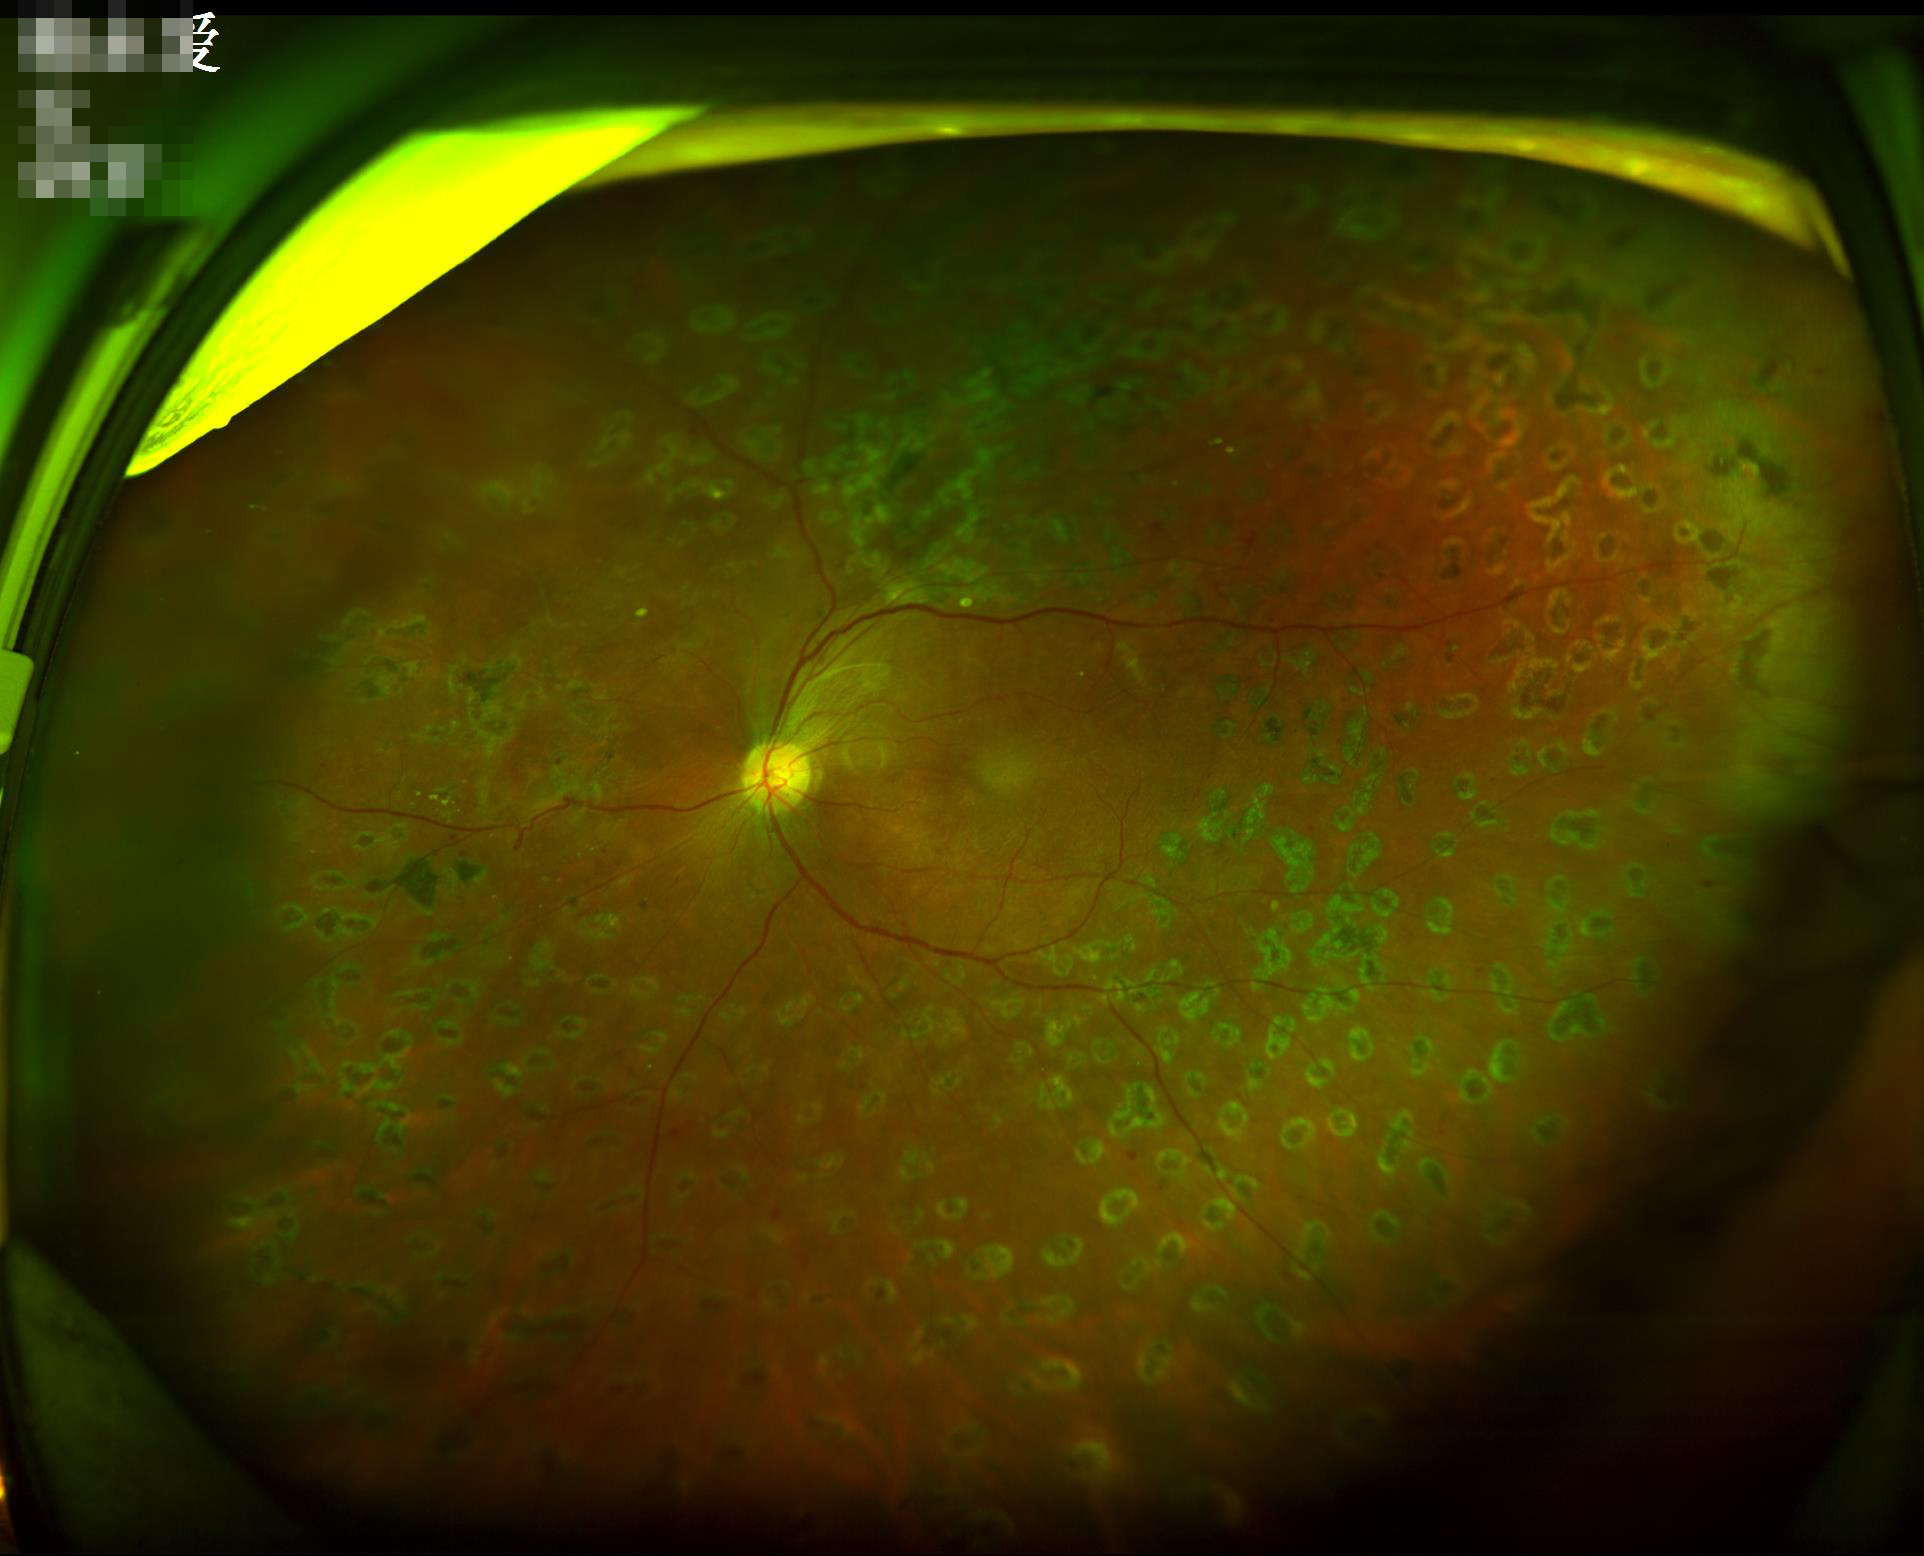

{
  "contrast": "adequate",
  "illumination": "adequate",
  "overall_quality": "satisfactory",
  "clarity": "sharp"
}